Modified Davis classification — 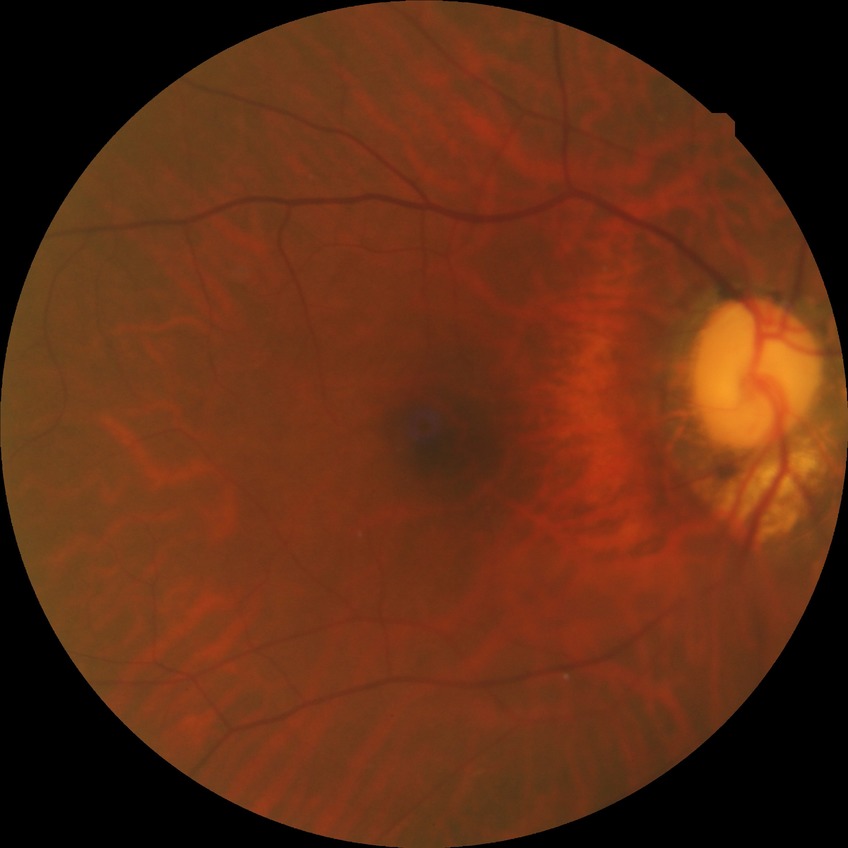

diabetic retinopathy (DR): NDR (no diabetic retinopathy).